Color fundus image: 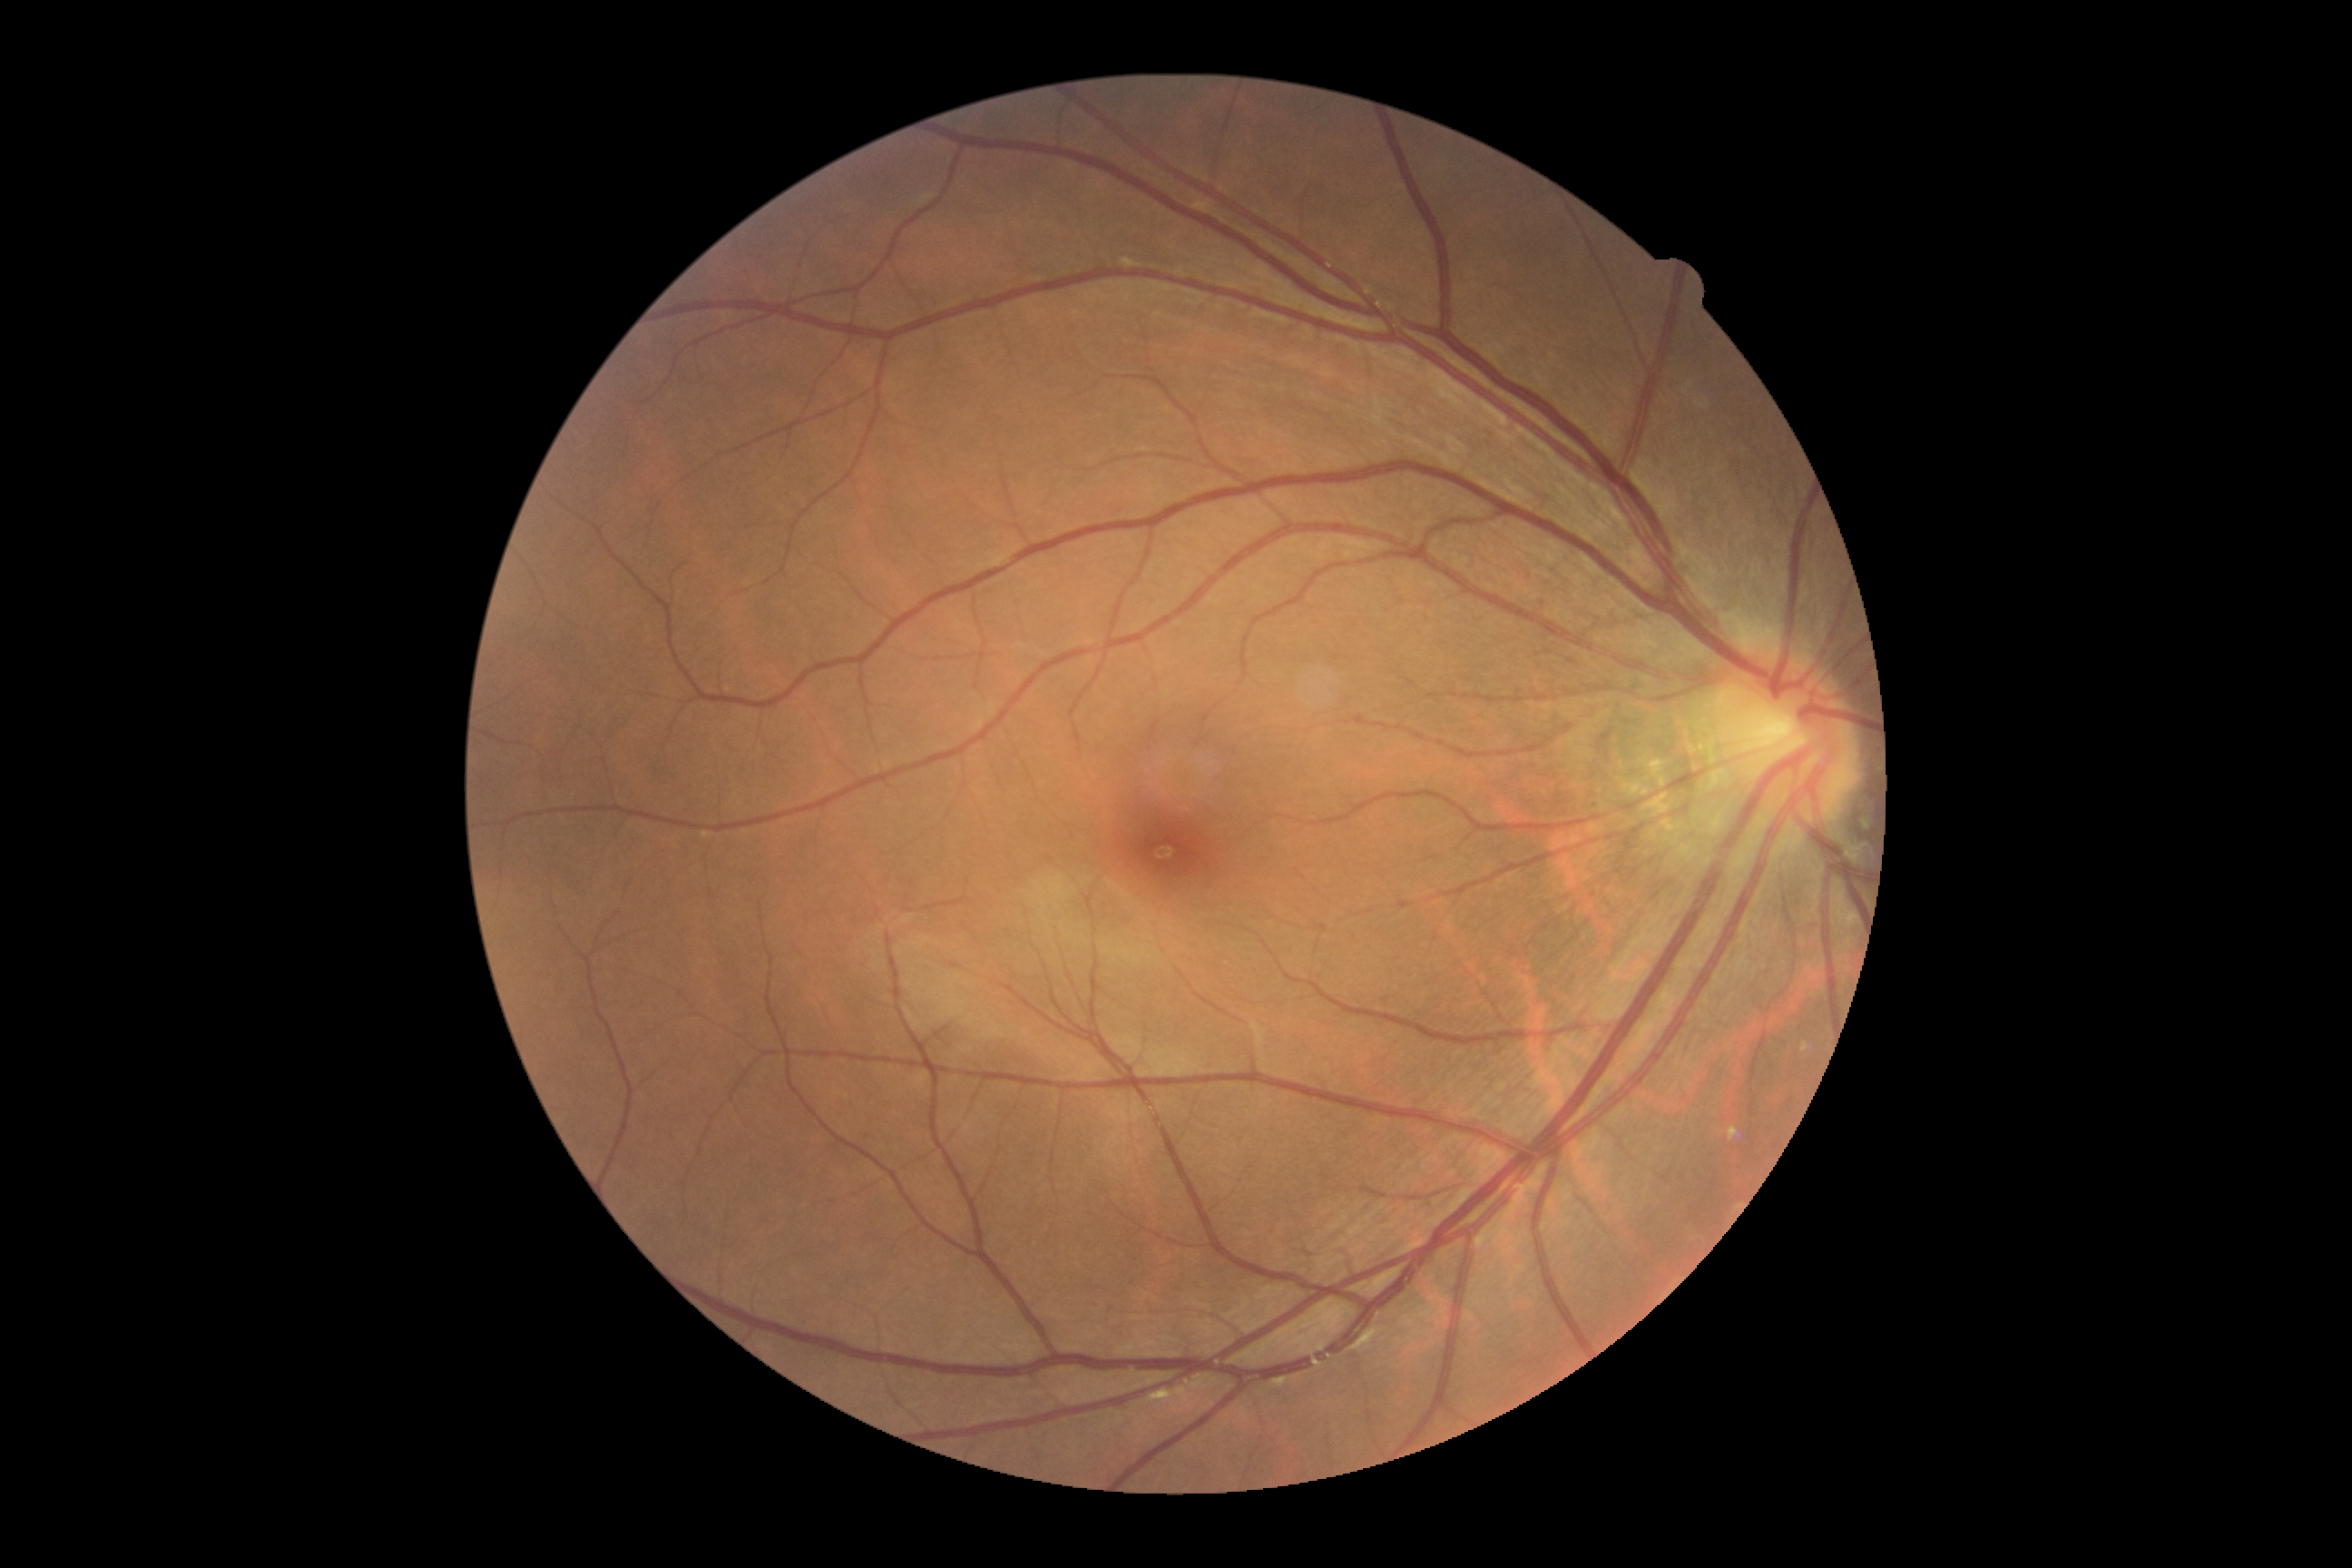

Diabetic retinopathy is 0.